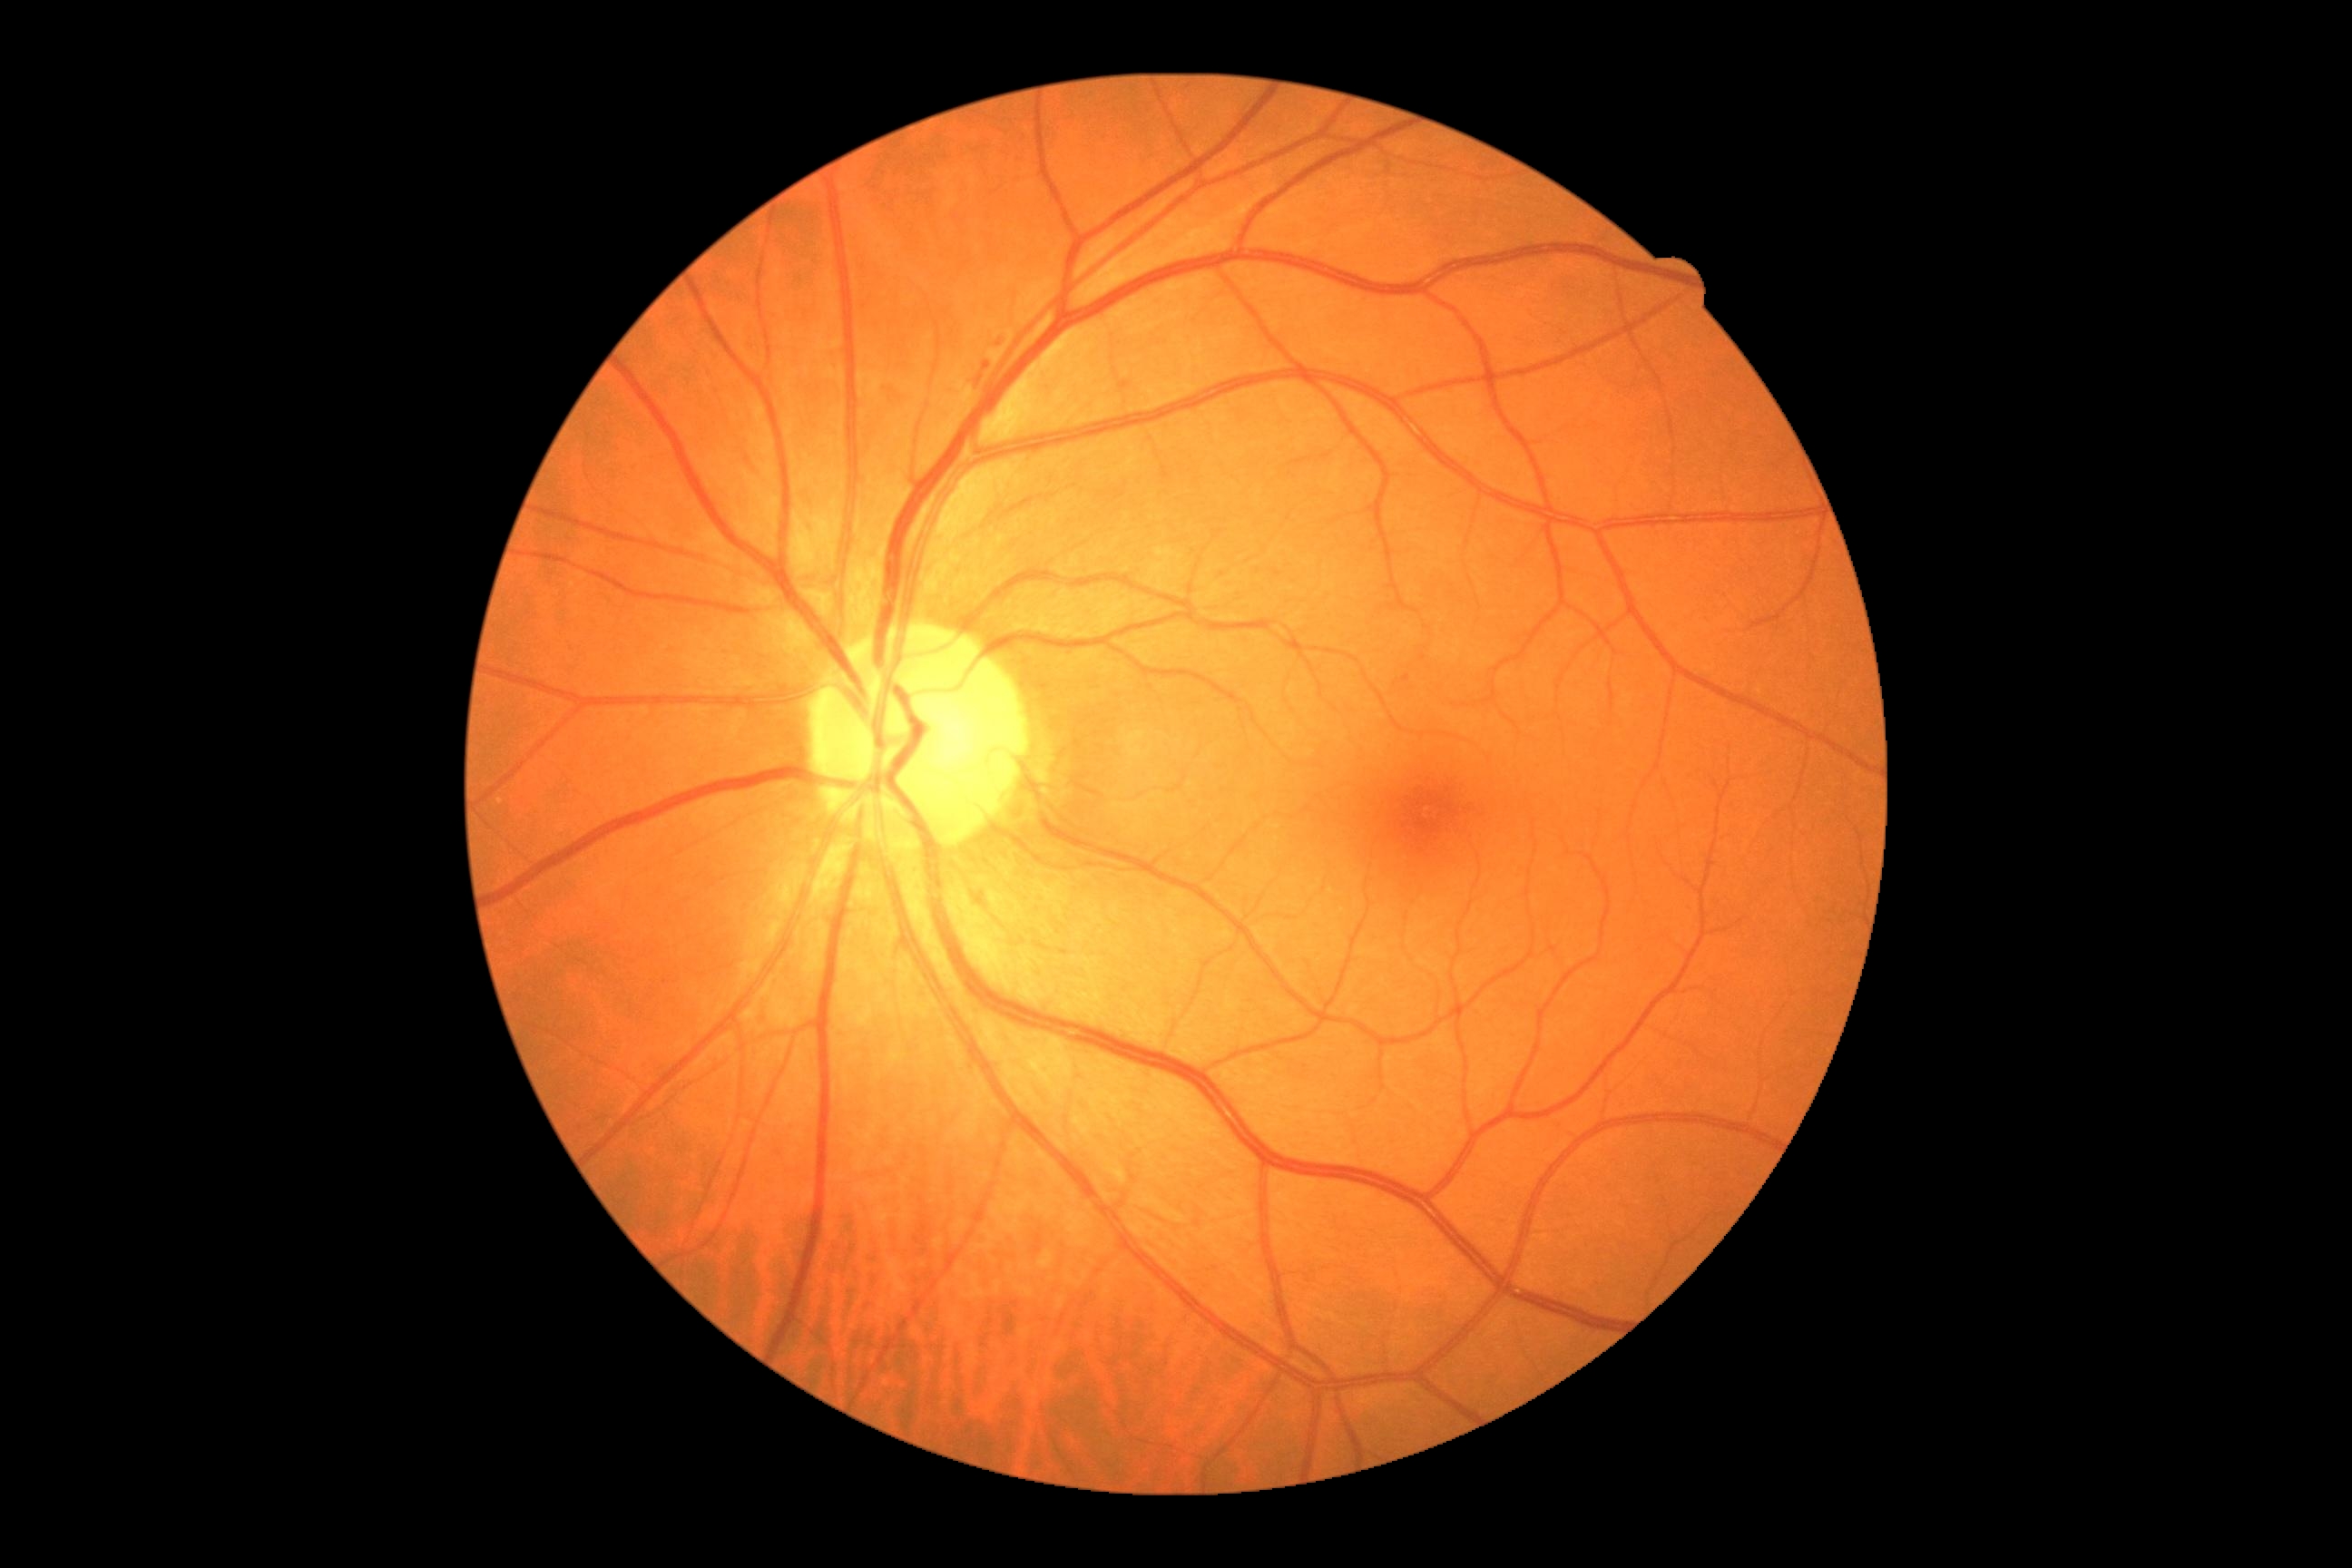
Retinopathy is grade 2 (moderate NPDR).
The retinopathy is classified as non-proliferative diabetic retinopathy.